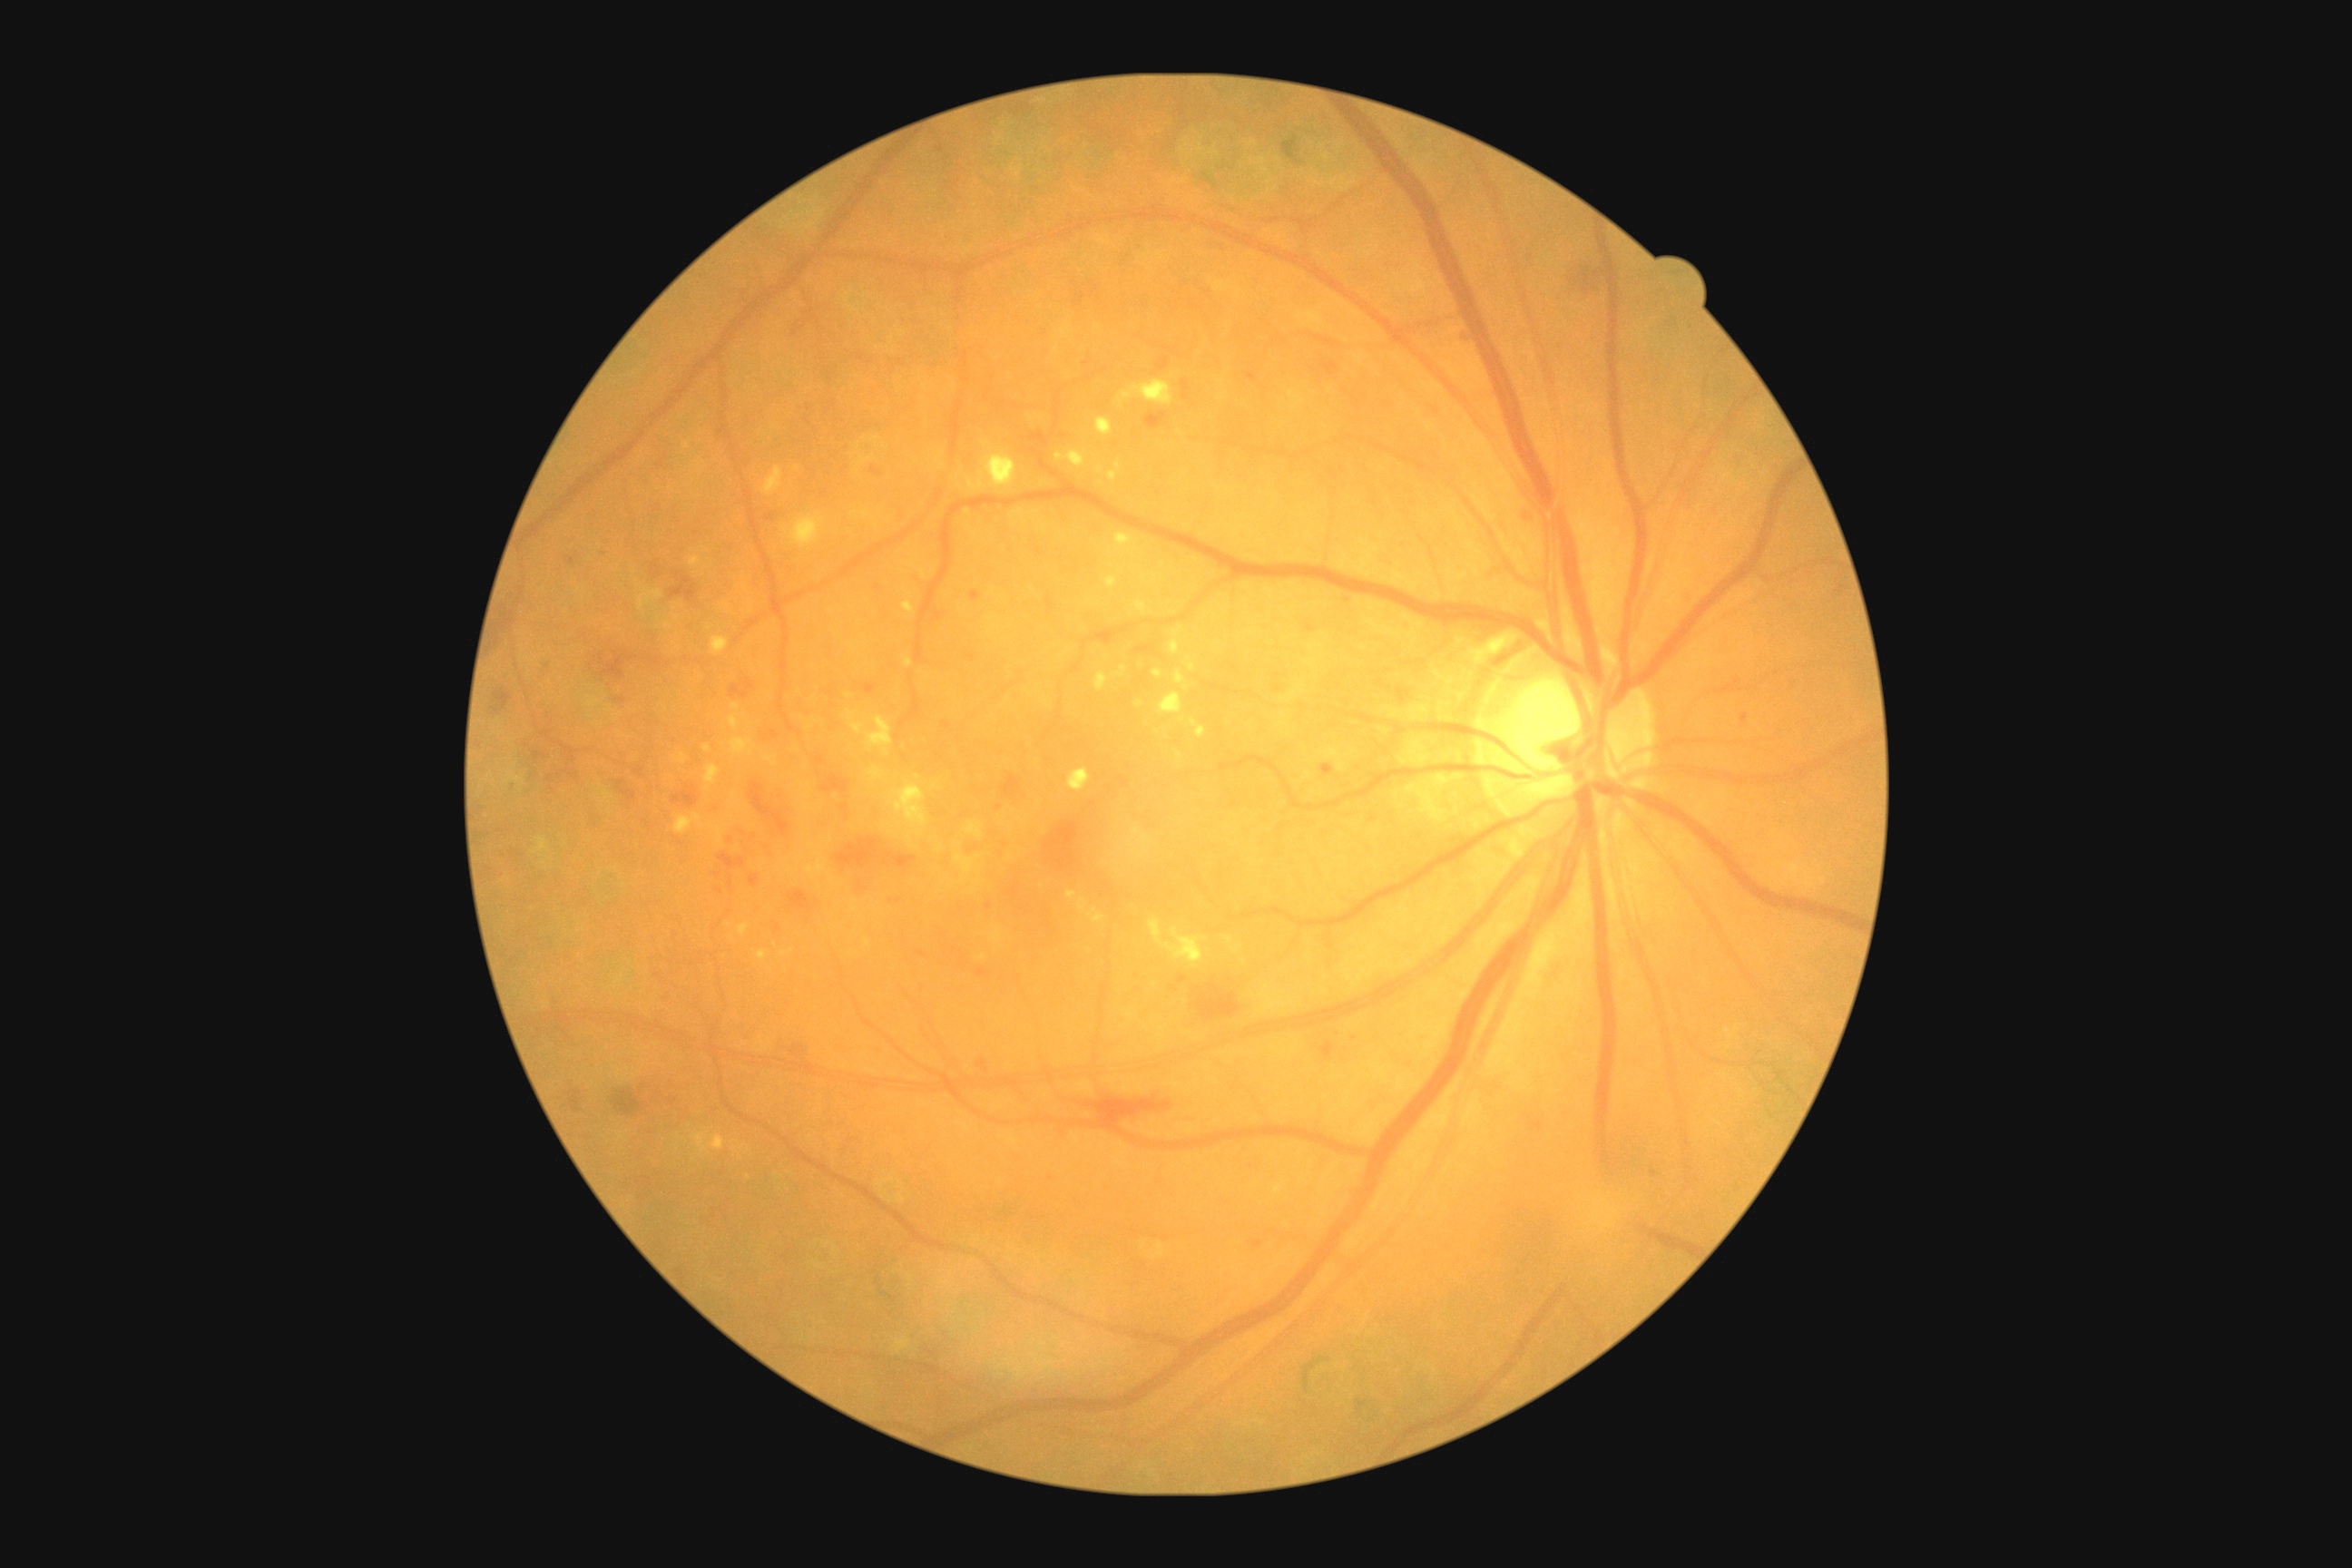
Diabetic retinopathy (DR): 2/4 — more than just microaneurysms but less than severe NPDR.